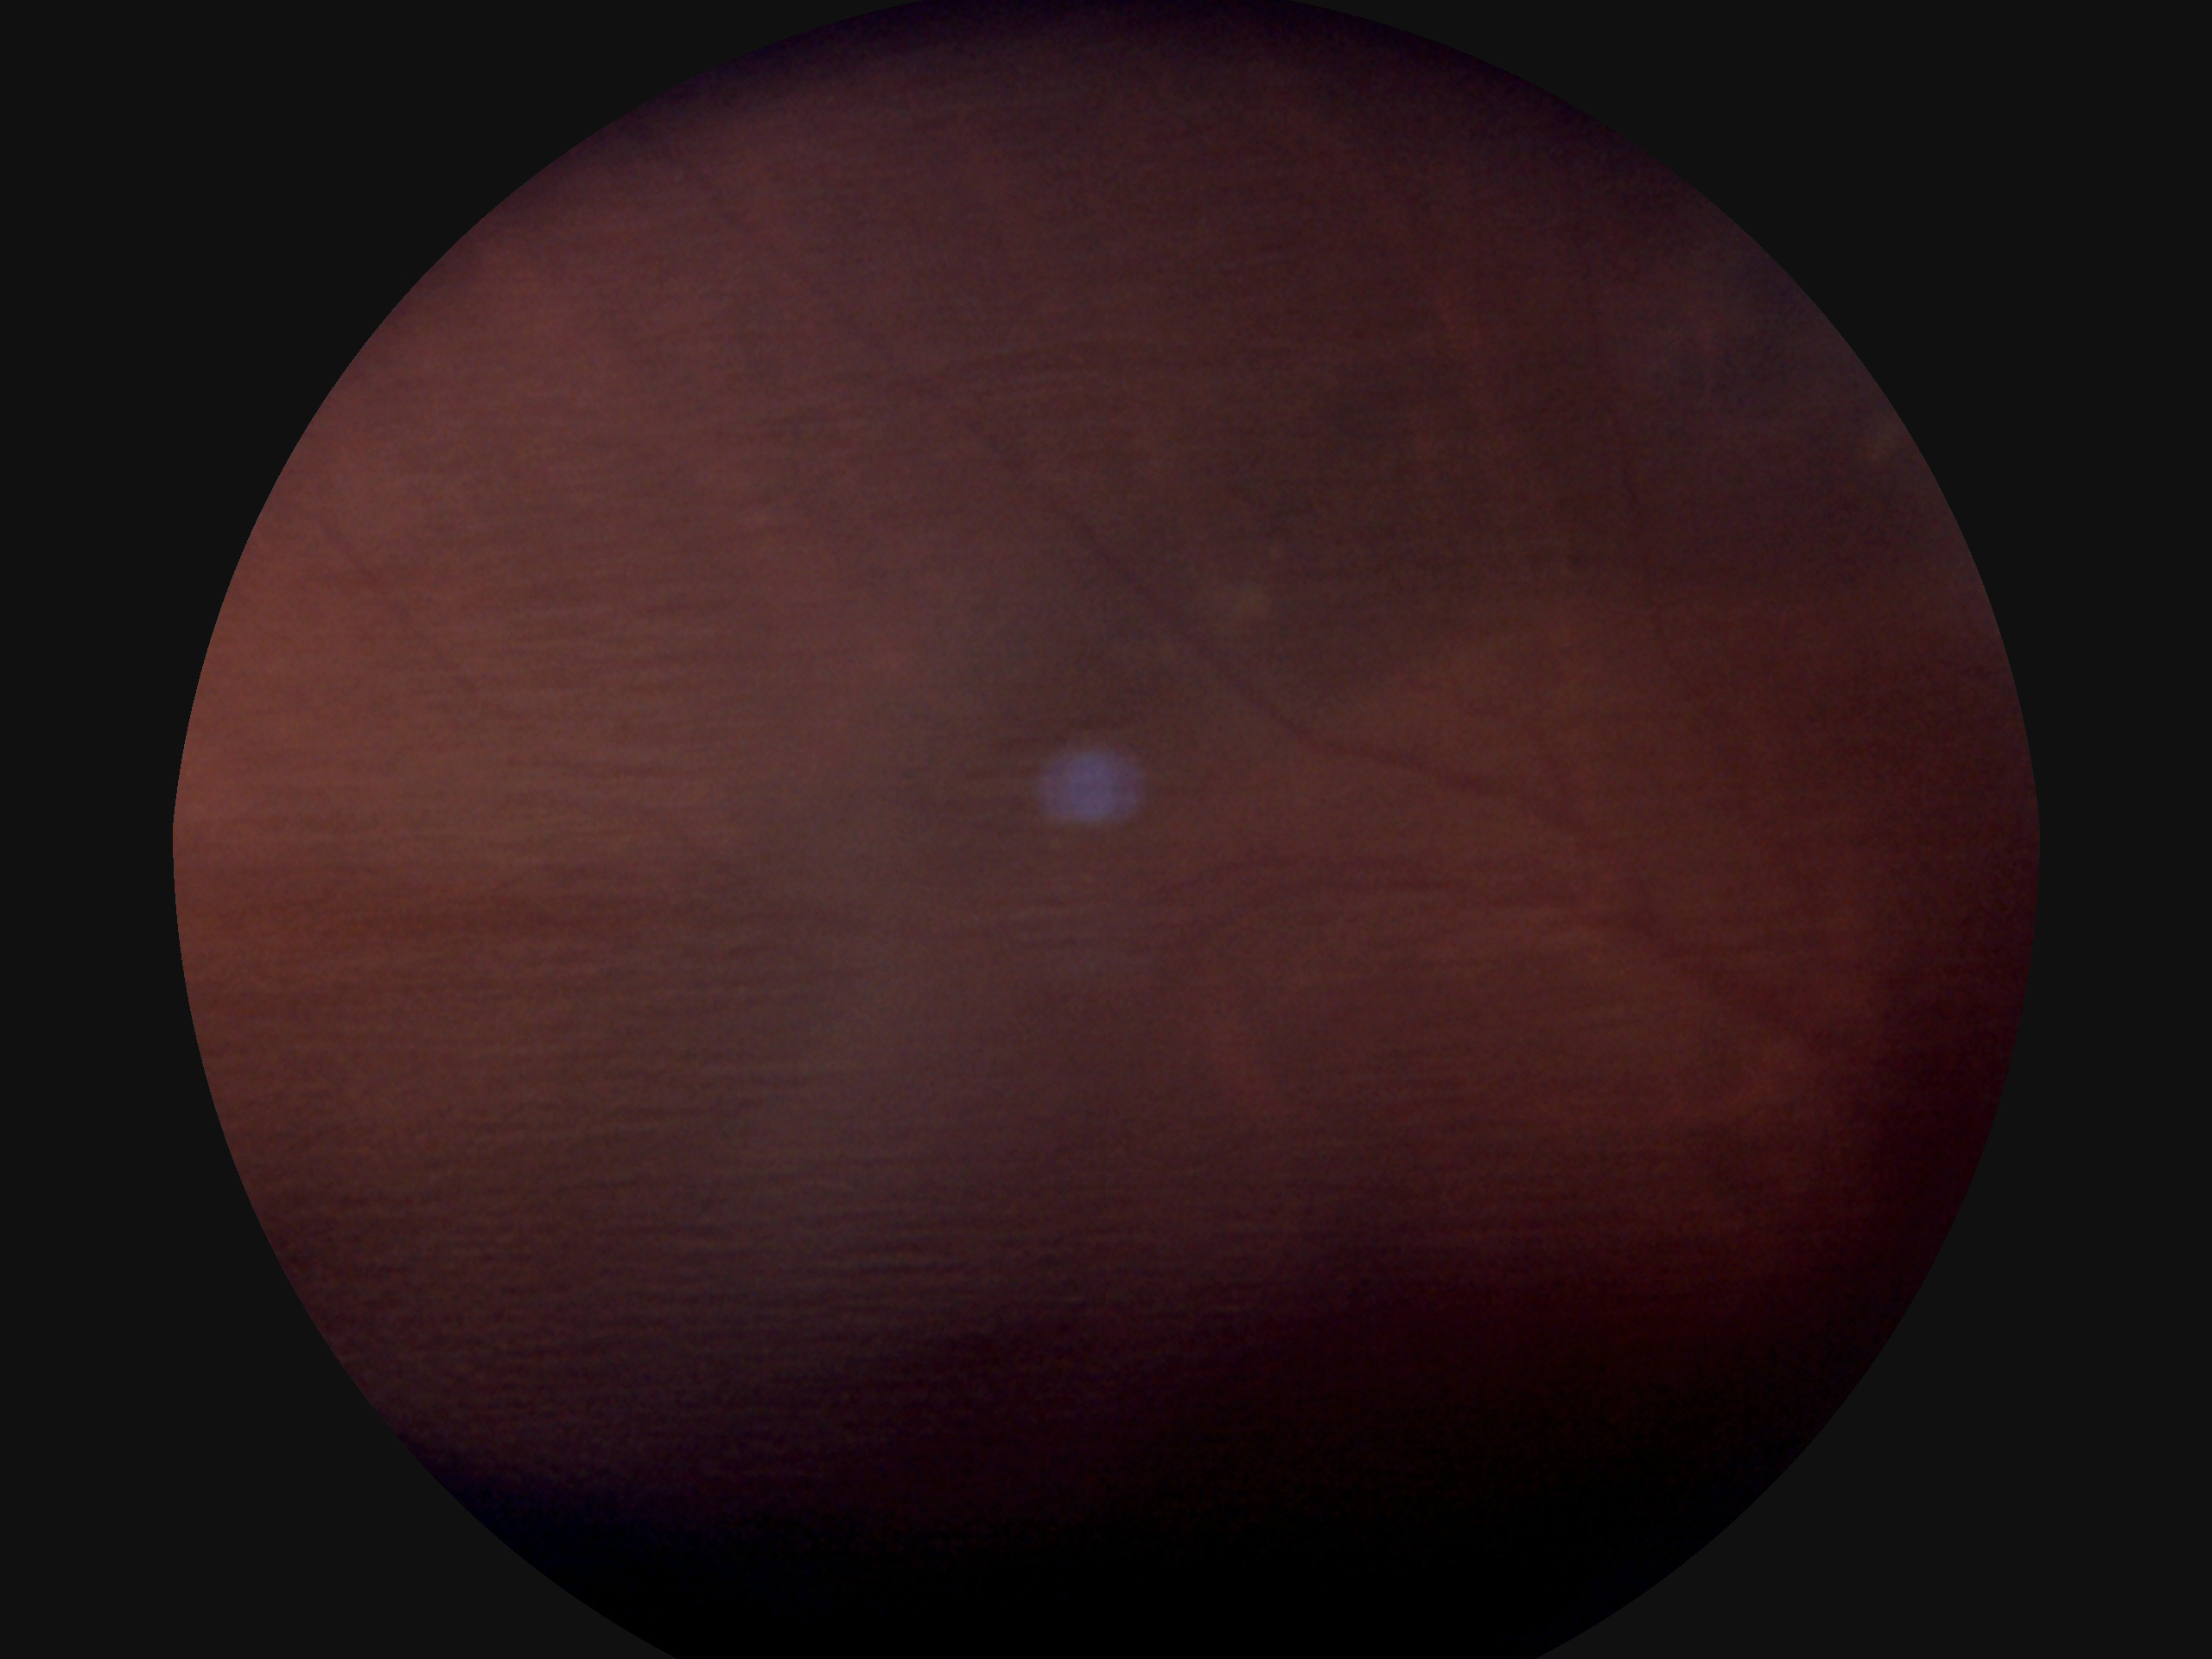

Annotations:
- DR grade — ungradable due to poor image quality